1932 by 1932 pixels · 45° field of view · retinal fundus photograph: 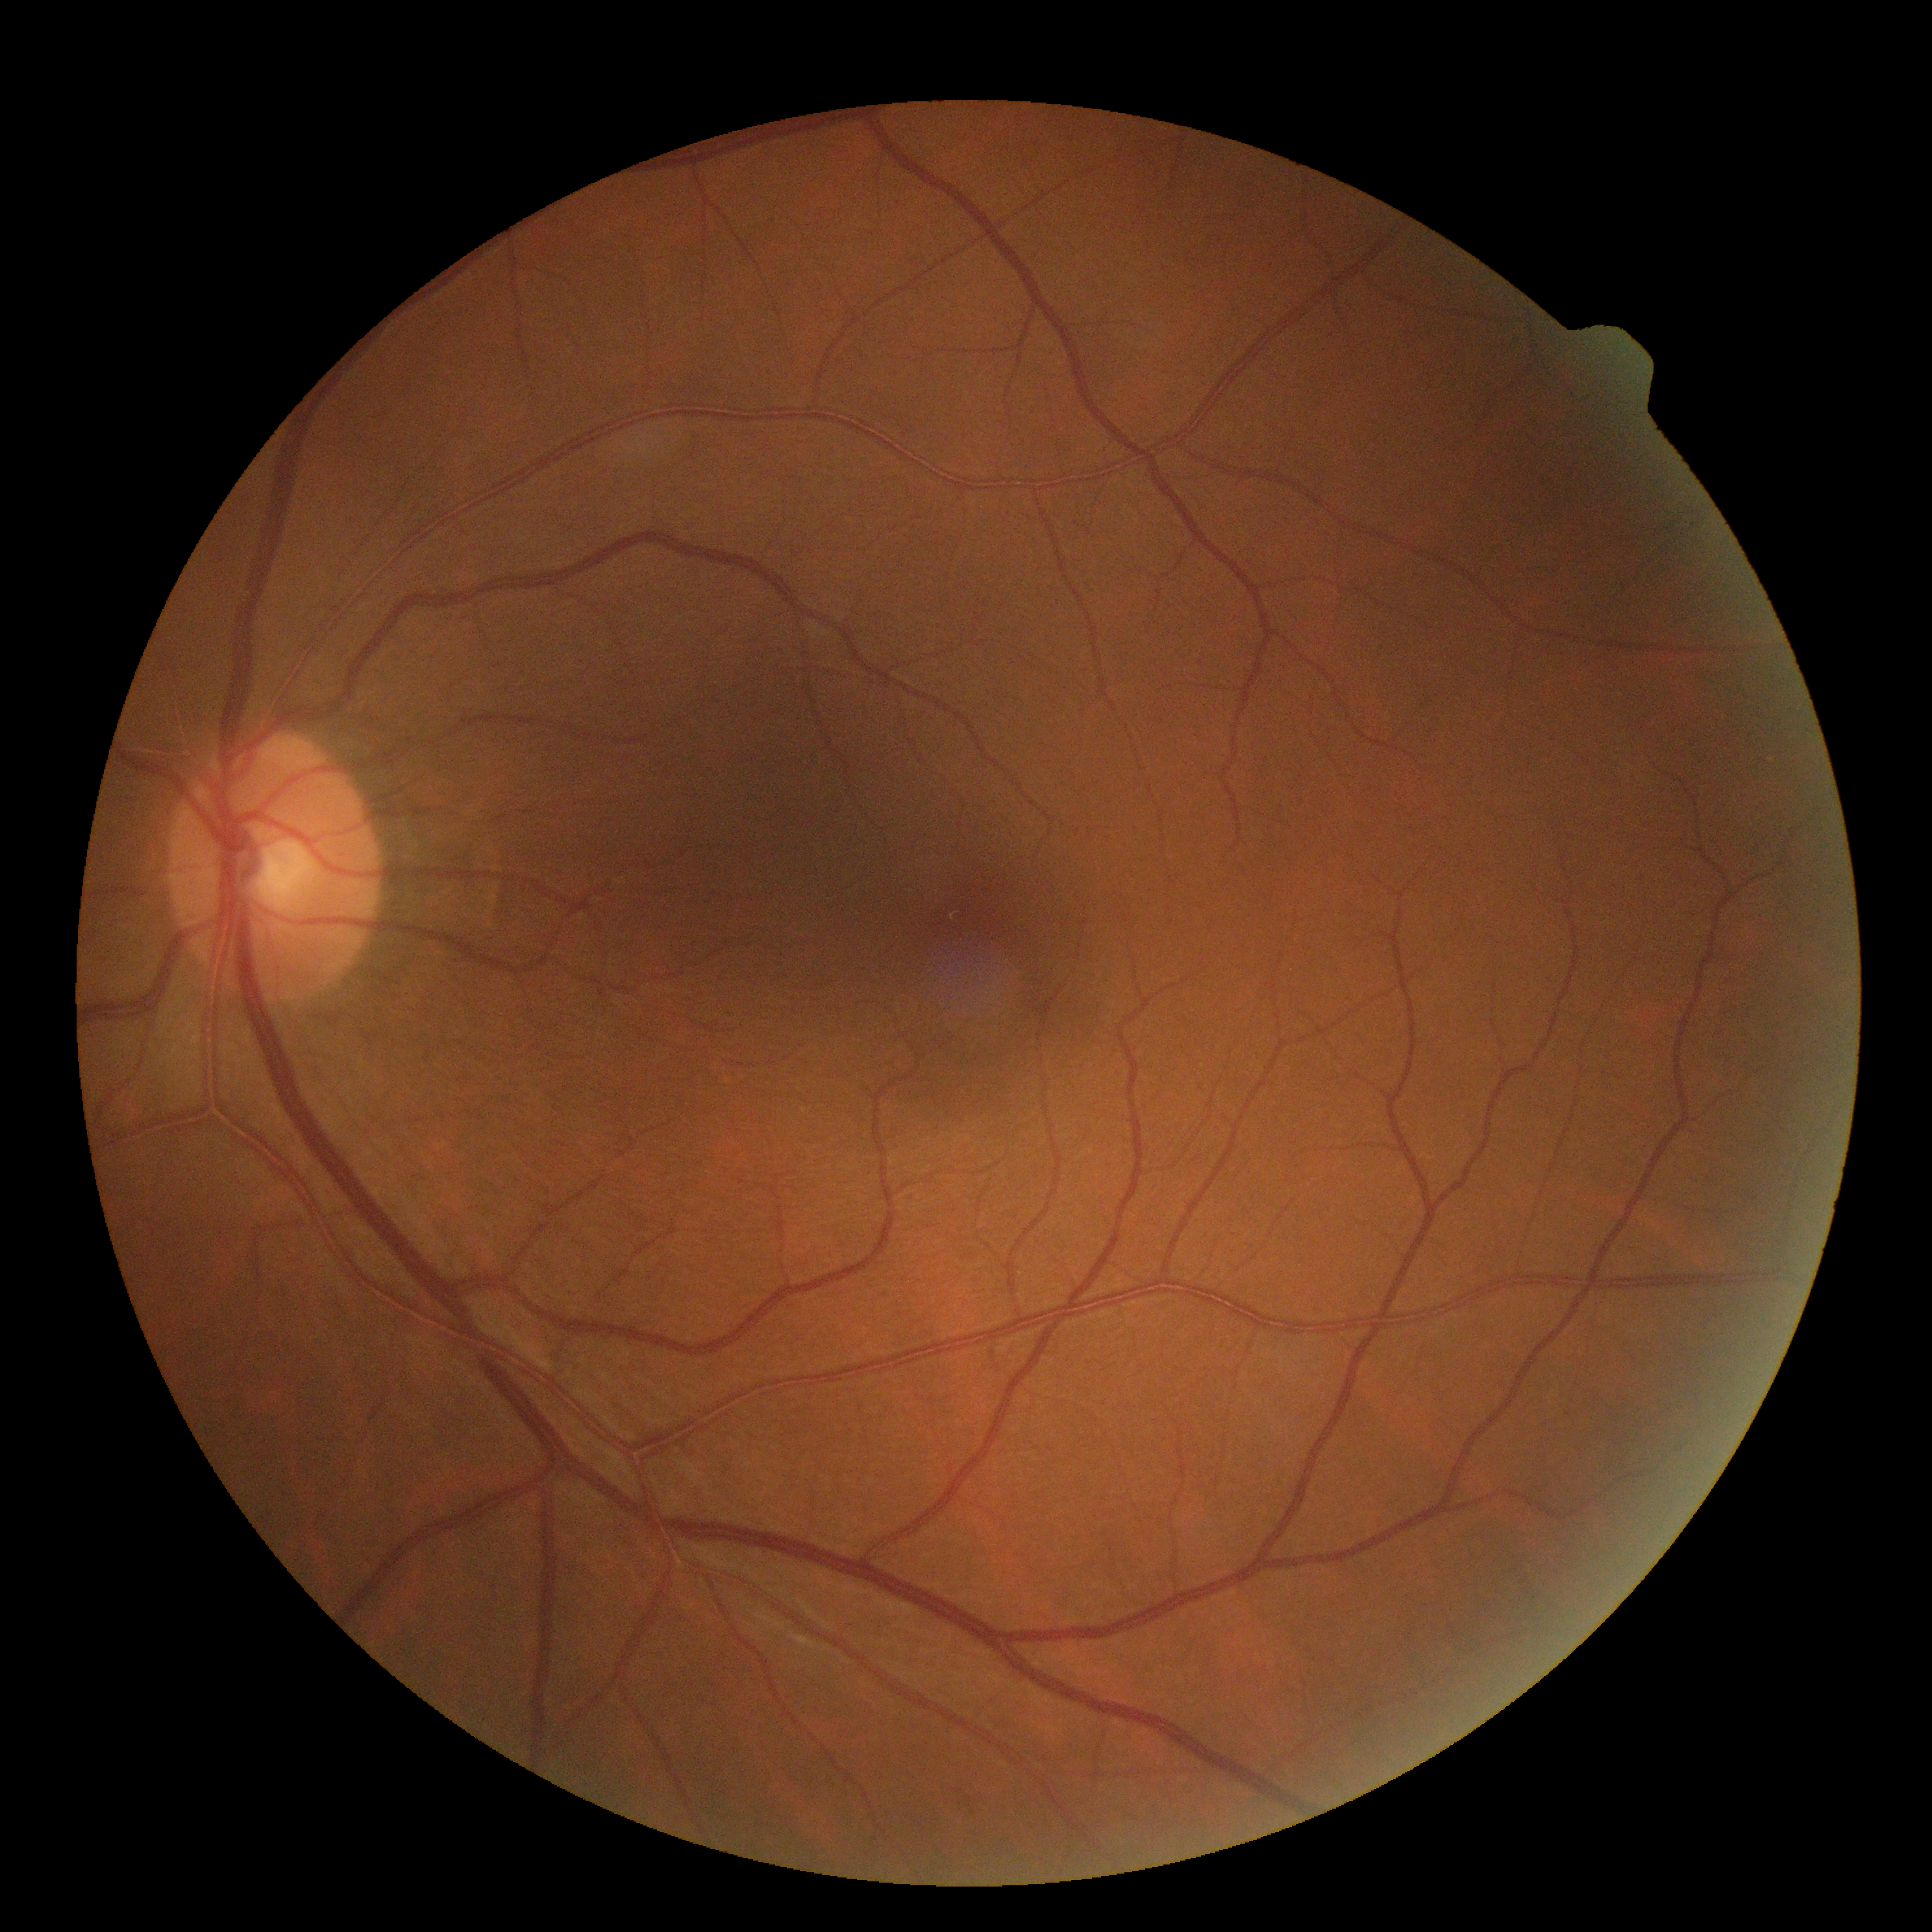
DR impression=no signs of DR, retinopathy grade=0.